FOV: 45 degrees, 2352 x 1568 pixels, color fundus photograph: 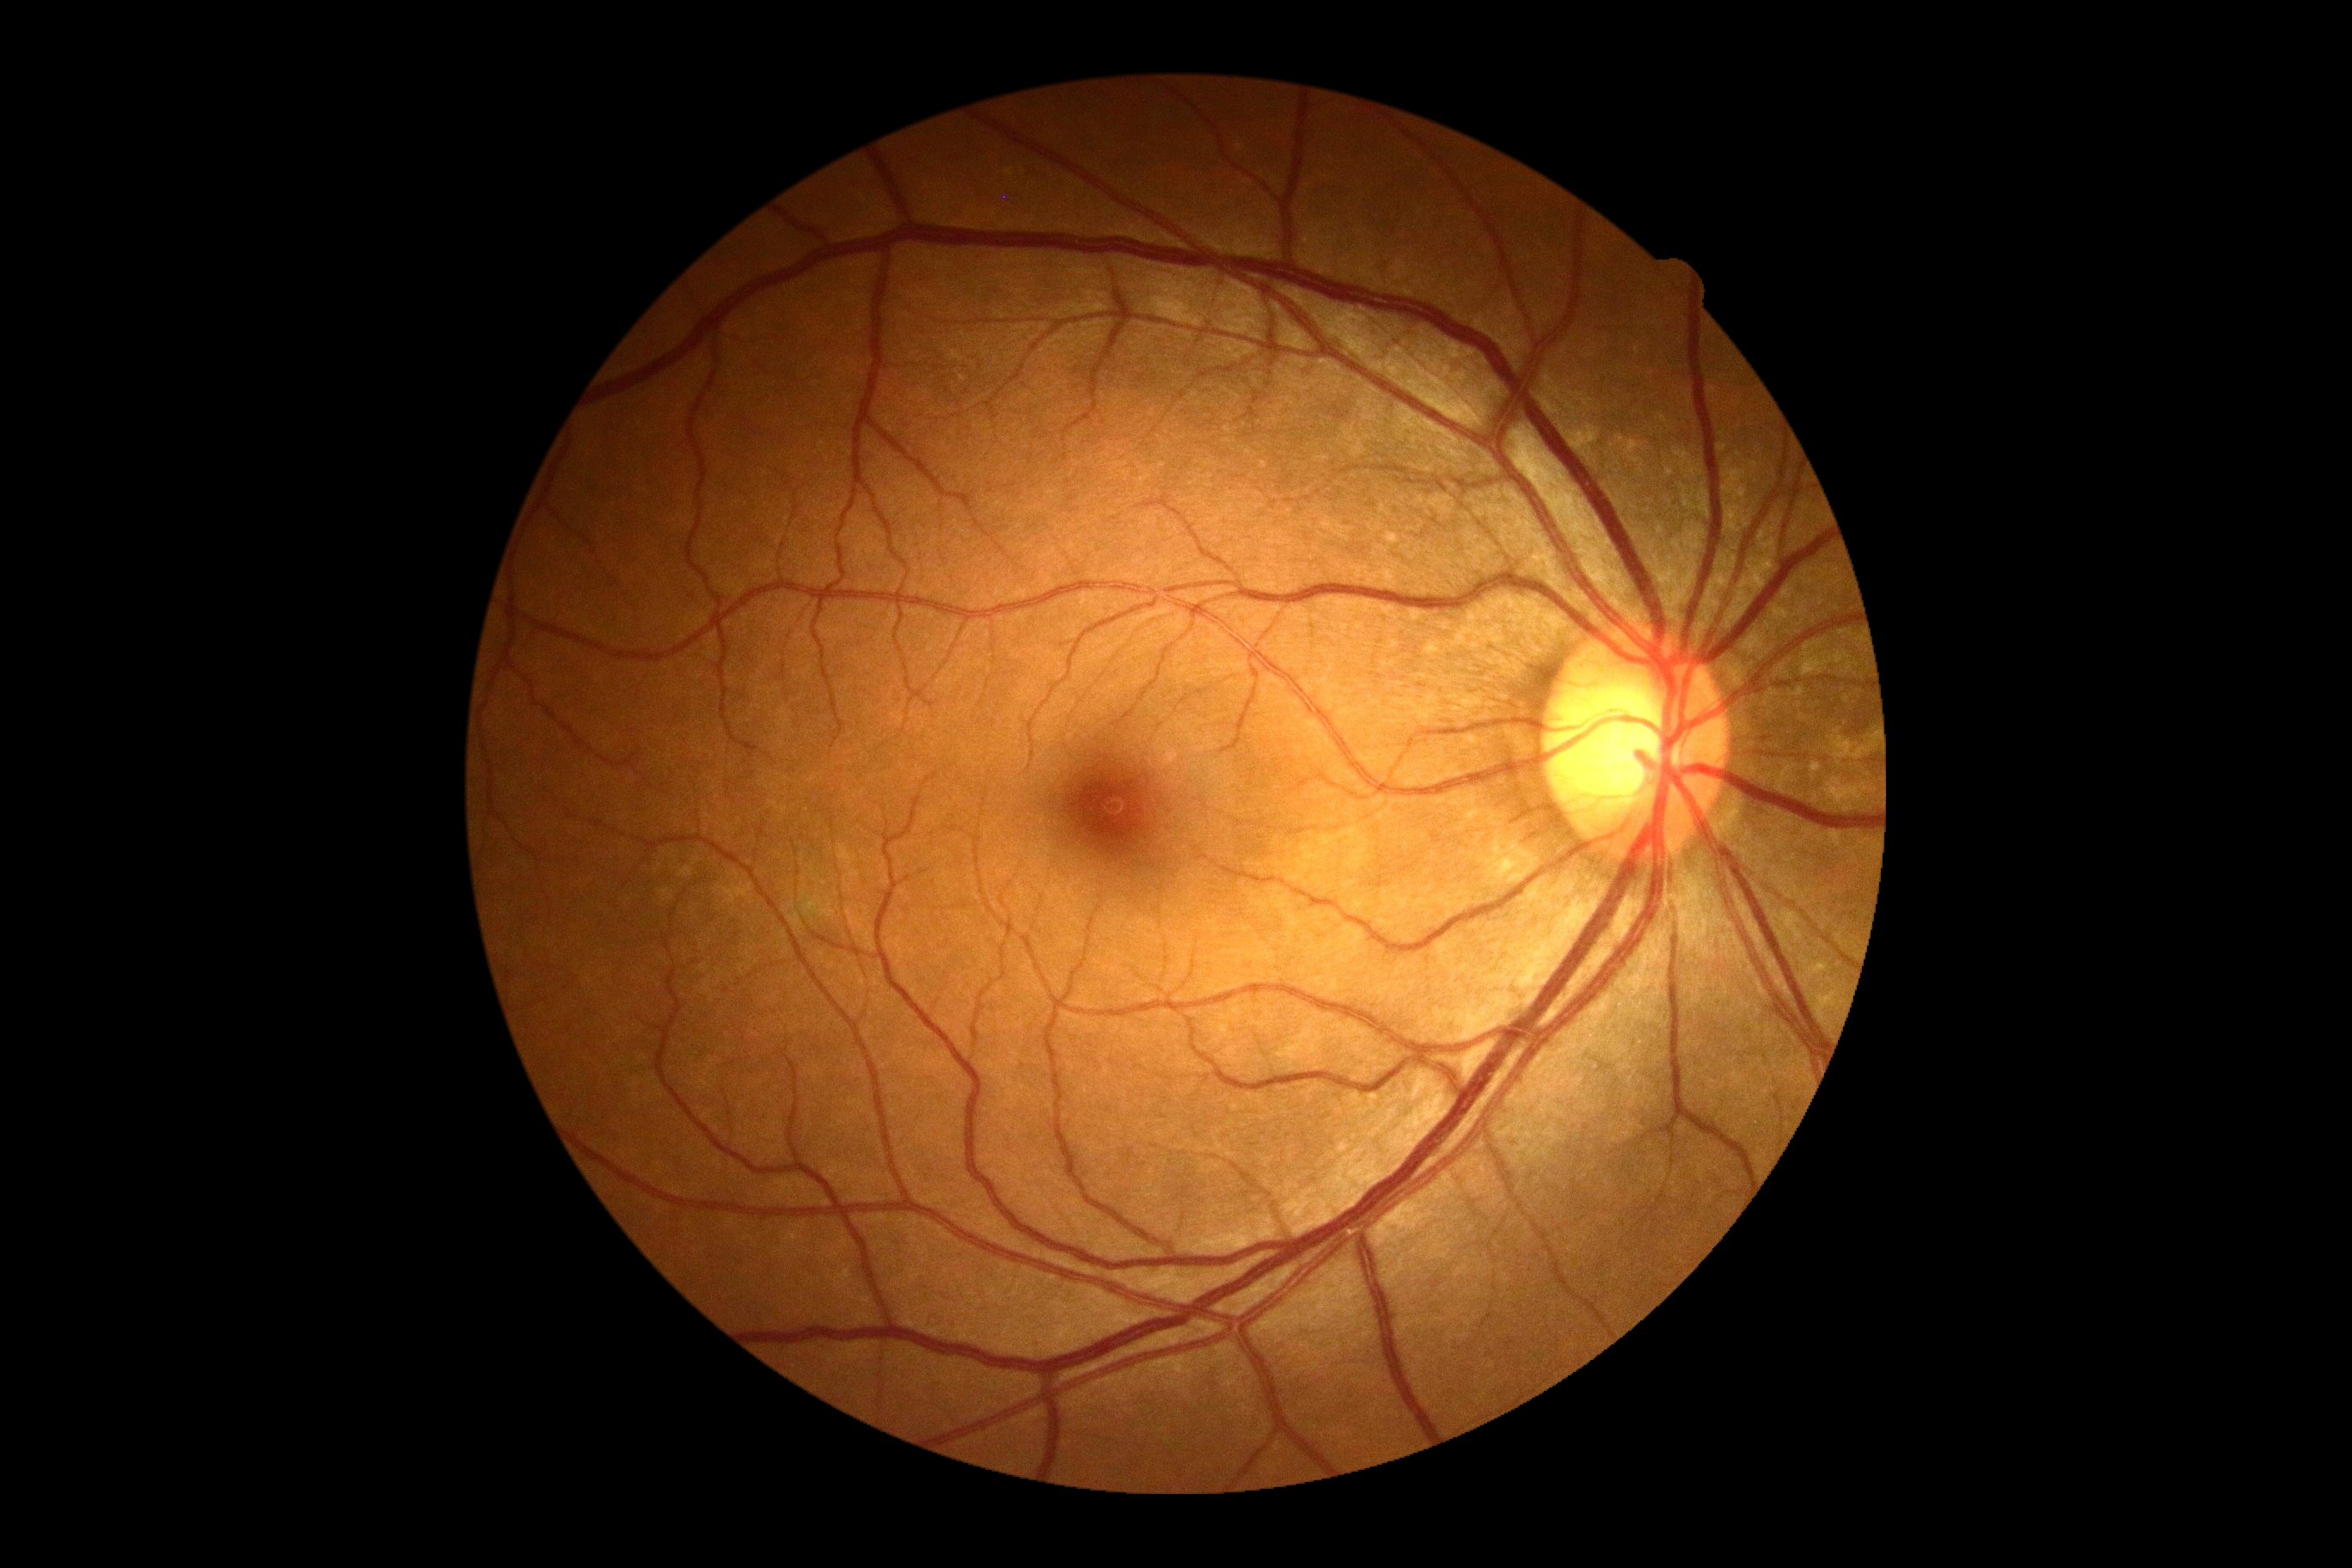 retinopathy: 0/4 — no visible signs of diabetic retinopathy.